848 x 848 pixels; 45° FOV; fundus photo — 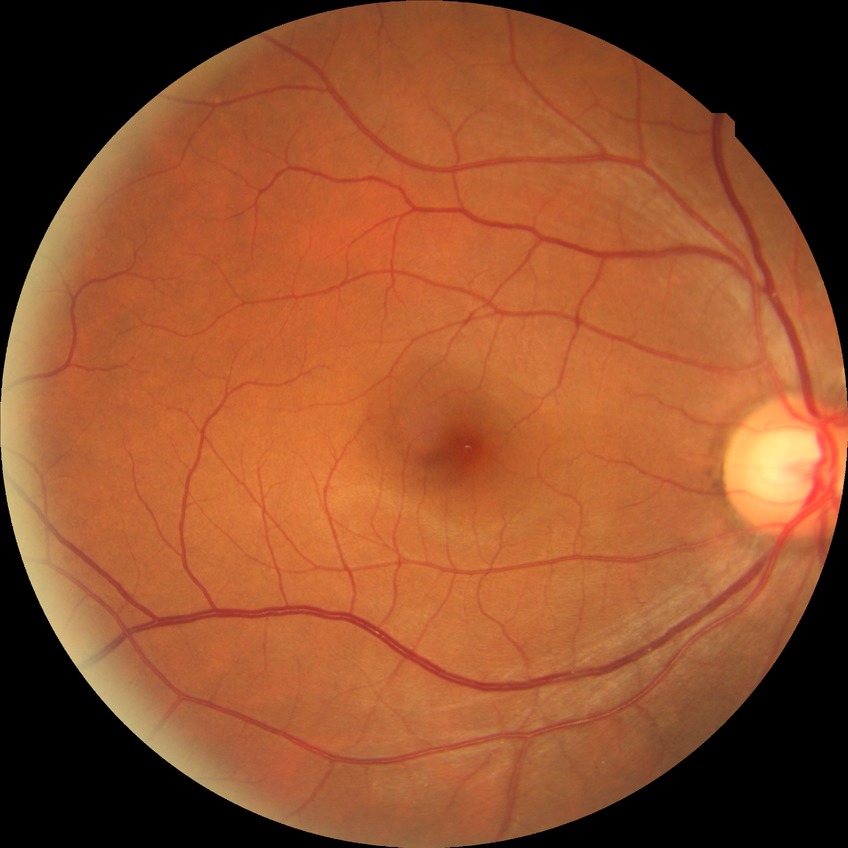

Davis grade is NDR.
No diabetic retinal disease findings.